640x480 · infant wide-field fundus photograph: 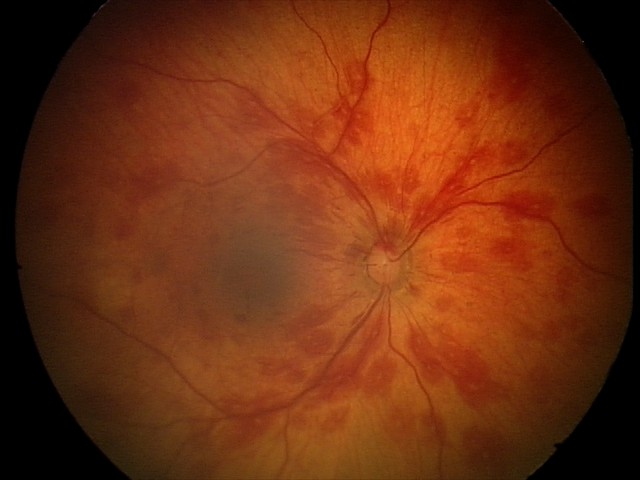

Screening examination consistent with retinal hemorrhages.